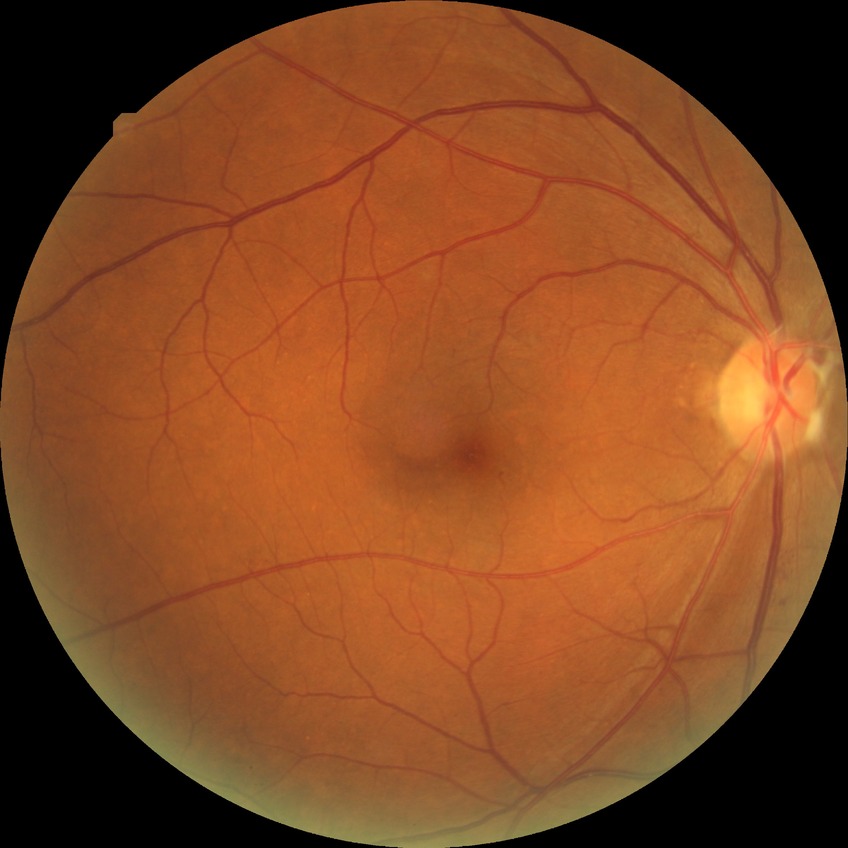

diabetic retinopathy (DR) = SDR (simple diabetic retinopathy)